DR severity per modified Davis staging, 45° FOV: 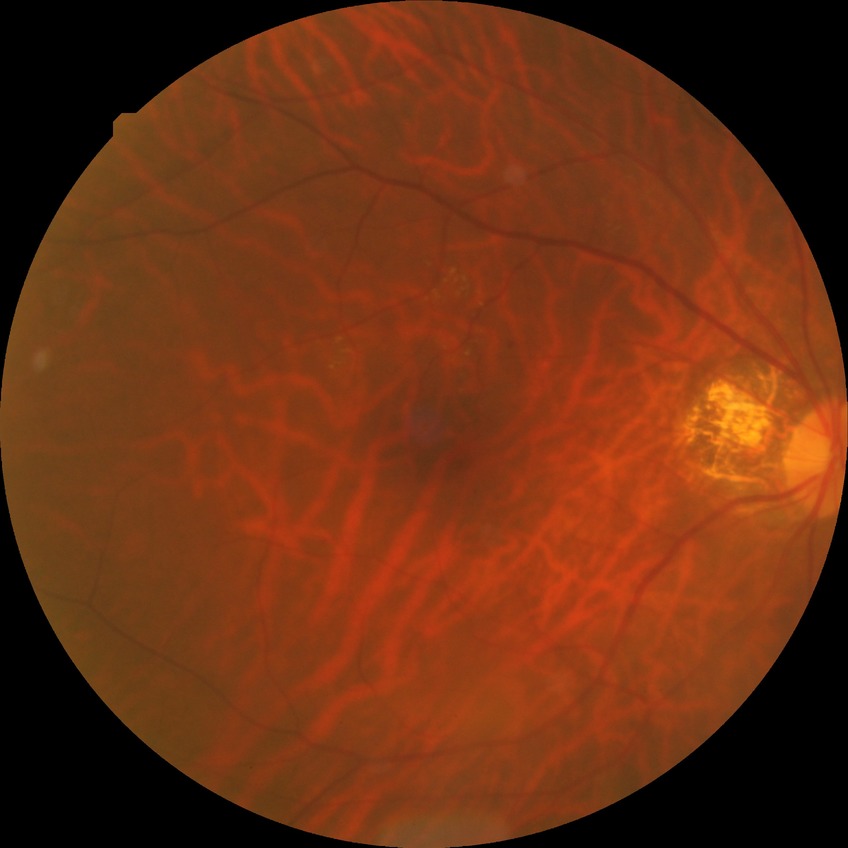   proliferative_class: non-proliferative diabetic retinopathy
  davis_grade: SDR